Image size 1440x1080 · captured with the Natus RetCam Envision (130° field of view) · wide-field fundus photograph from neonatal ROP screening.
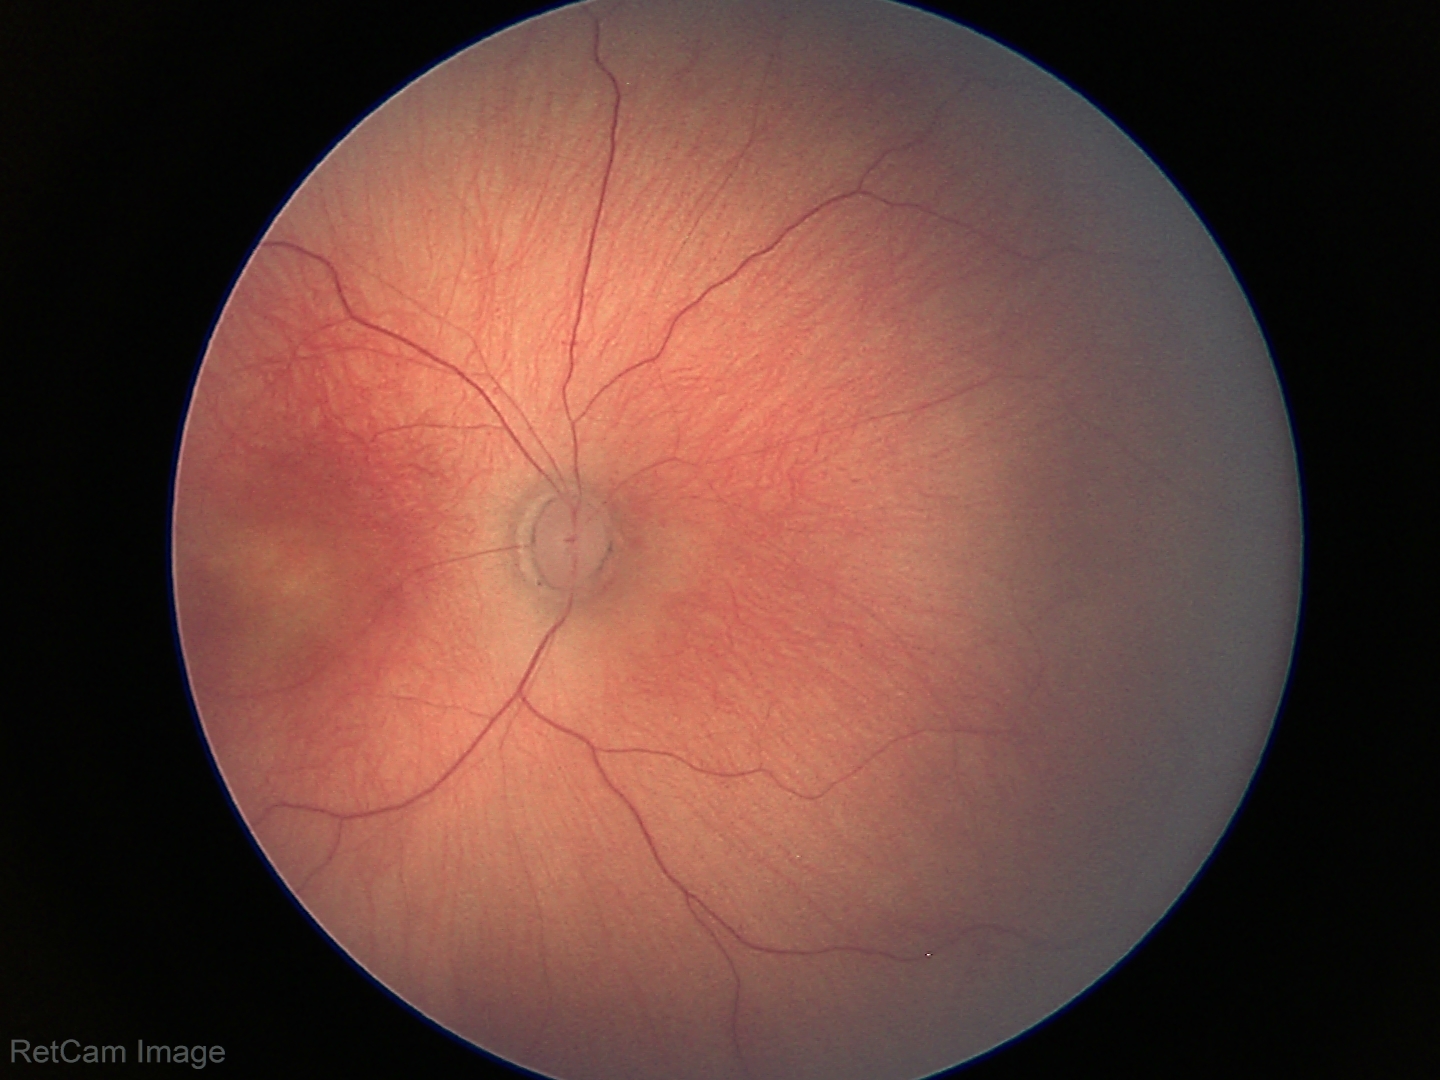

Finding: status post retinopathy of prematurity
plus disease: absent